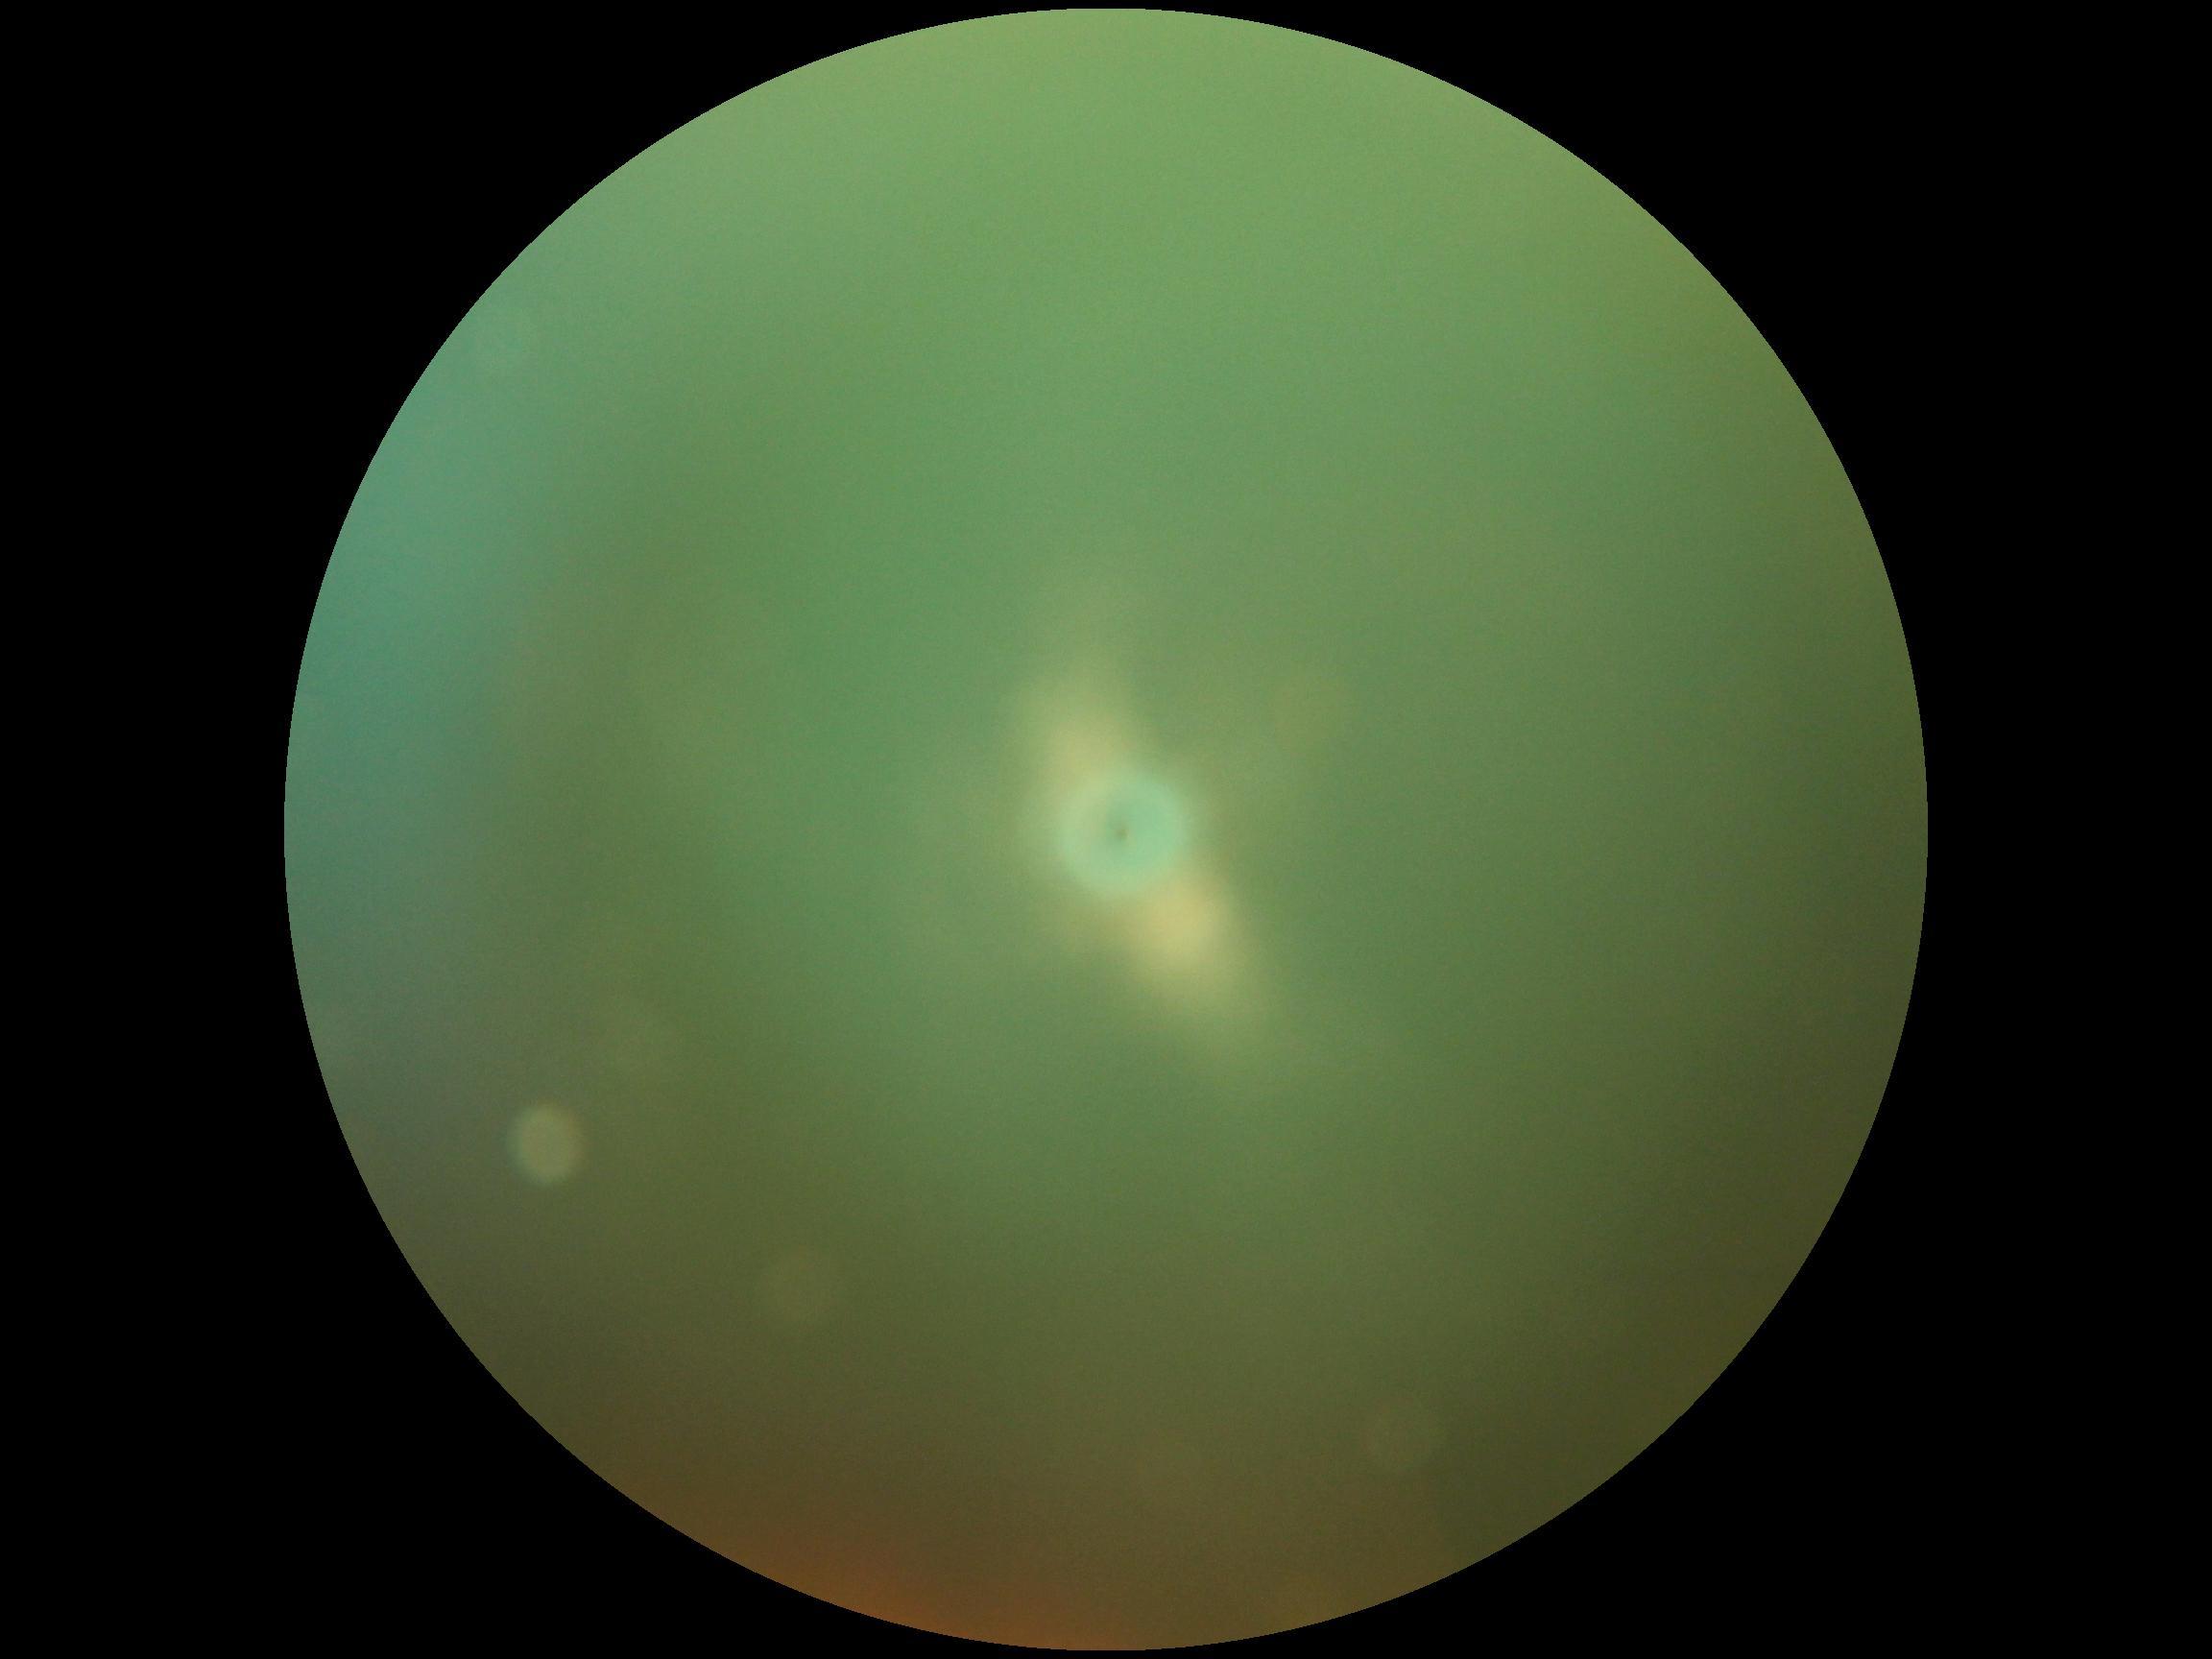 diabetic retinopathy (DR): ungradable due to poor image quality.